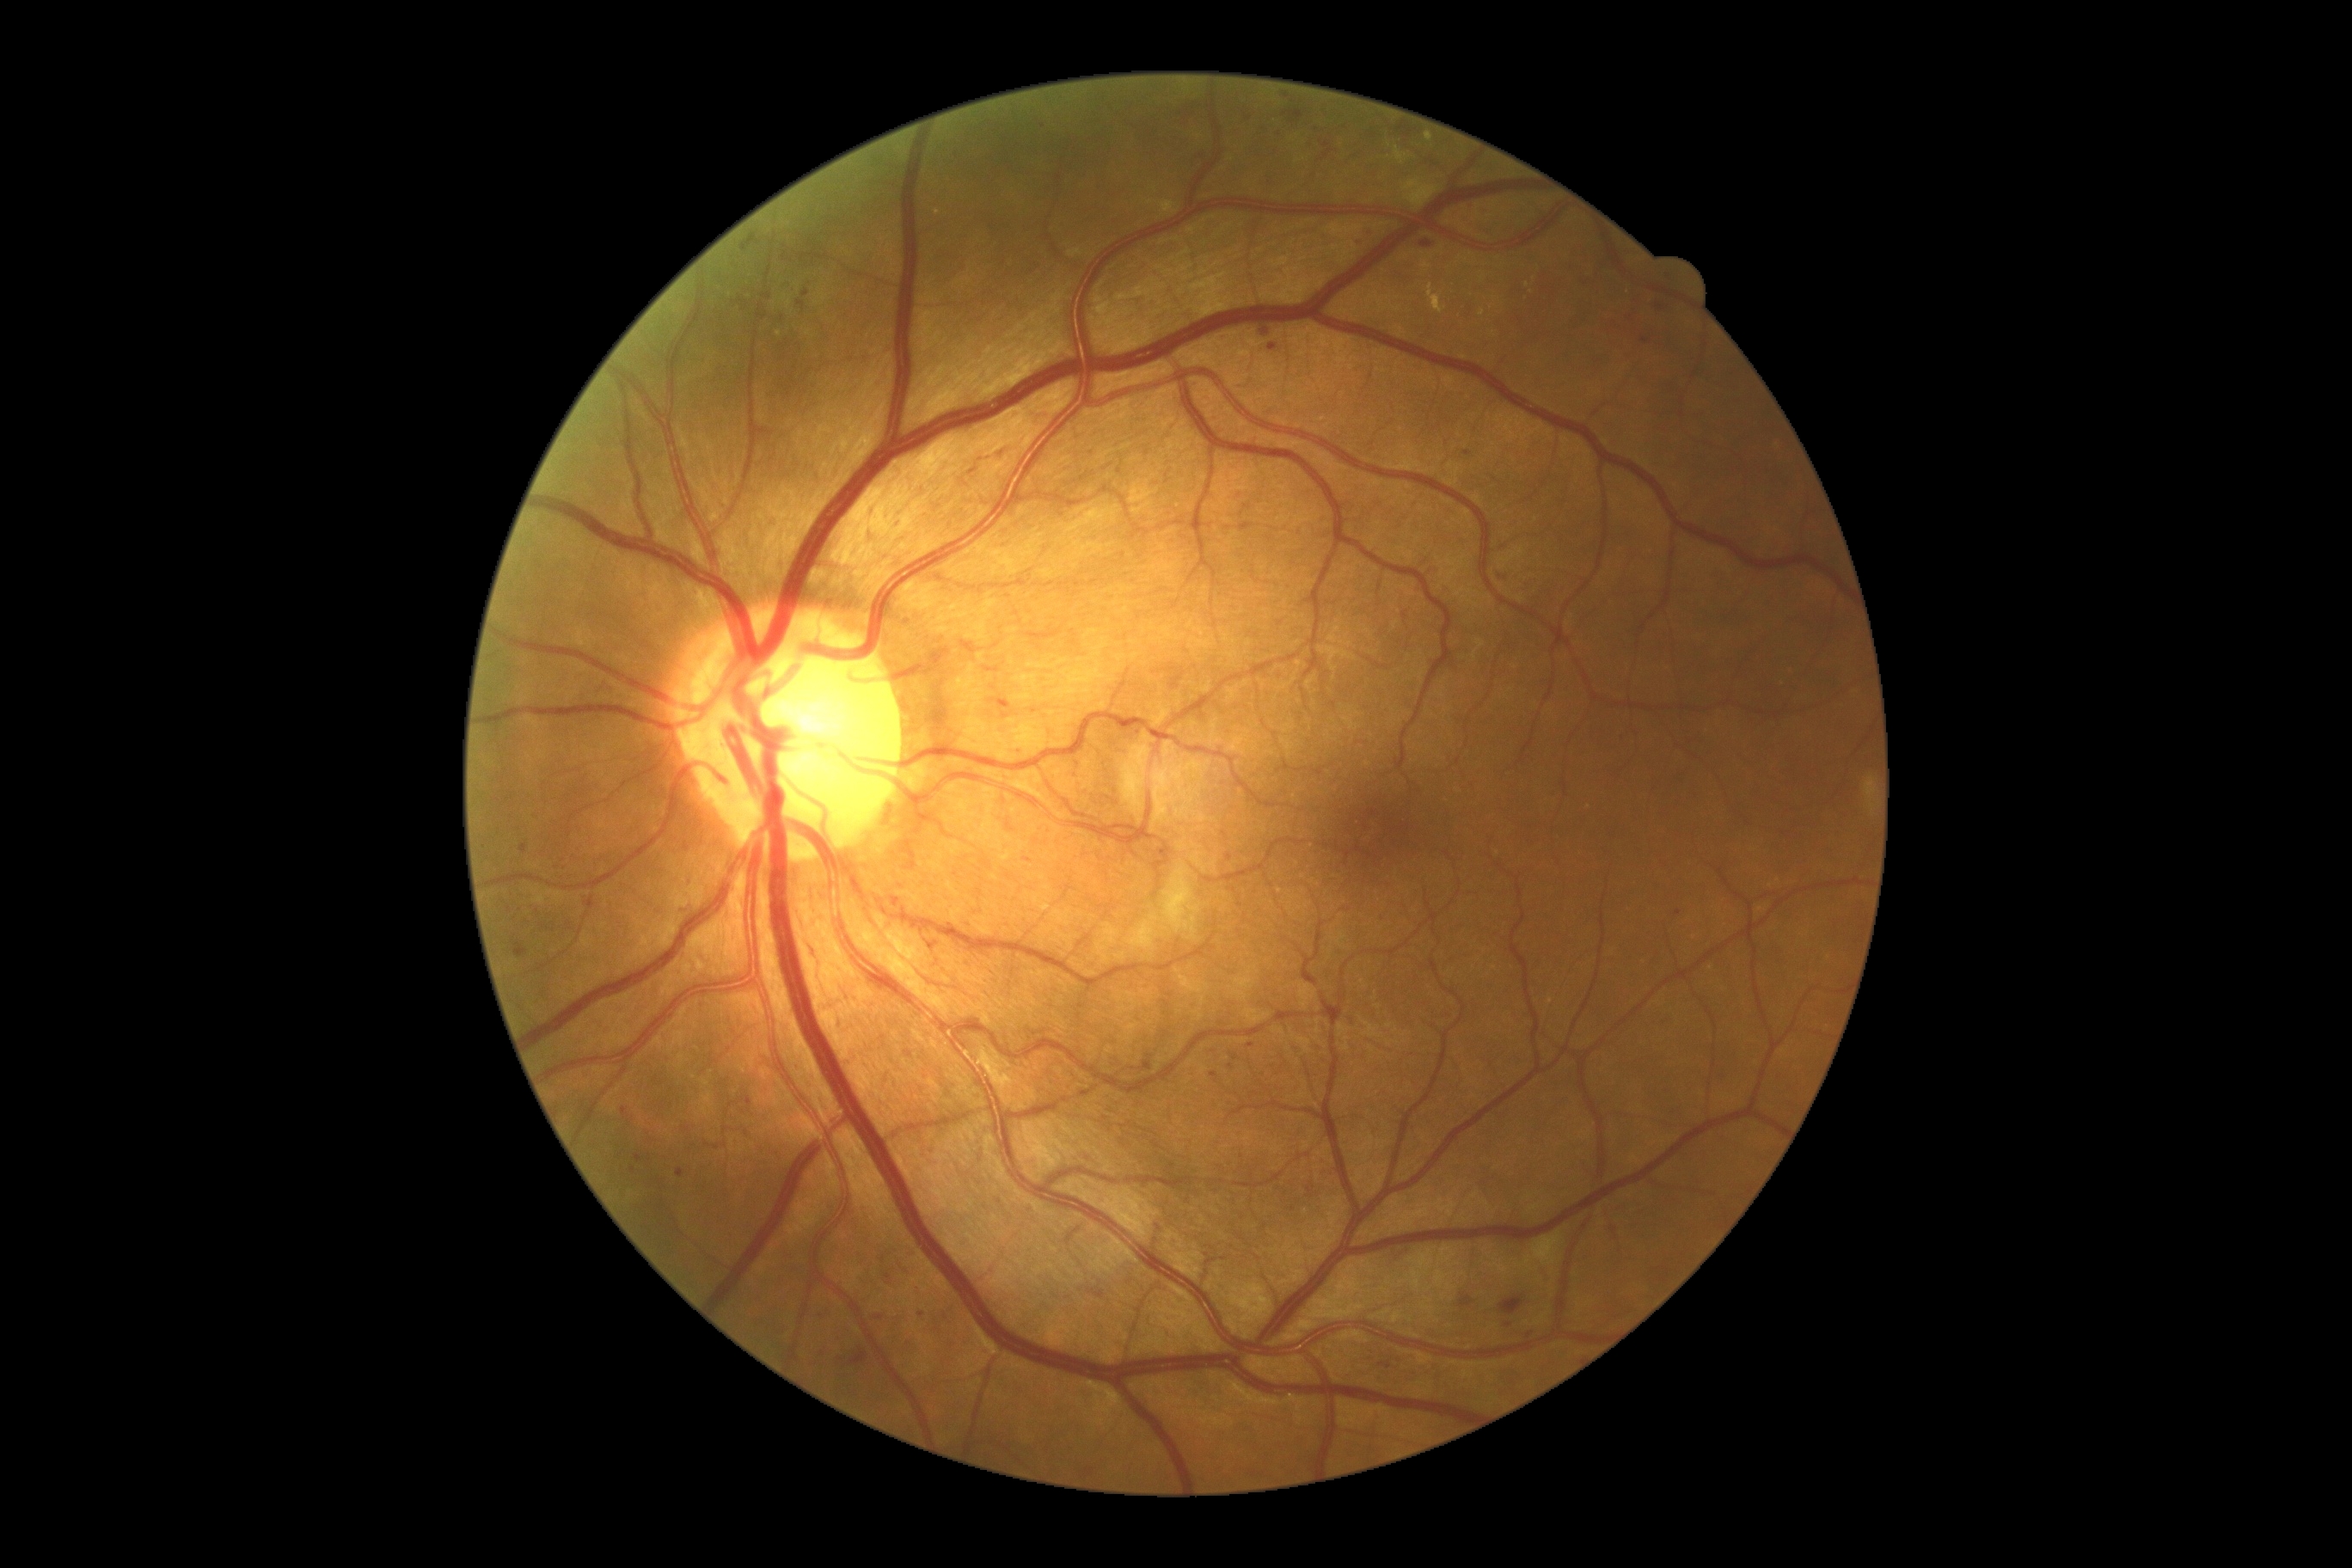

partial: true
dr_grade: 2
dr_grade_name: moderate NPDR
lesions:
  ma:
    - l=1278, t=670, r=1285, b=682
    - l=1464, t=451, r=1473, b=456
    - l=819, t=1311, r=826, b=1320
    - l=622, t=1108, r=628, b=1118
    - l=850, t=1349, r=867, b=1366
    - l=1141, t=1055, r=1153, b=1072
  ma_small_centers:
    - {"x": 1221, "y": 340}
    - {"x": 1189, "y": 112}
    - {"x": 1250, "y": 1046}
    - {"x": 879, "y": 1318}
    - {"x": 908, "y": 1054}
    - {"x": 742, "y": 301}
    - {"x": 1366, "y": 233}
    - {"x": 1235, "y": 1058}
    - {"x": 1646, "y": 341}